45-degree field of view
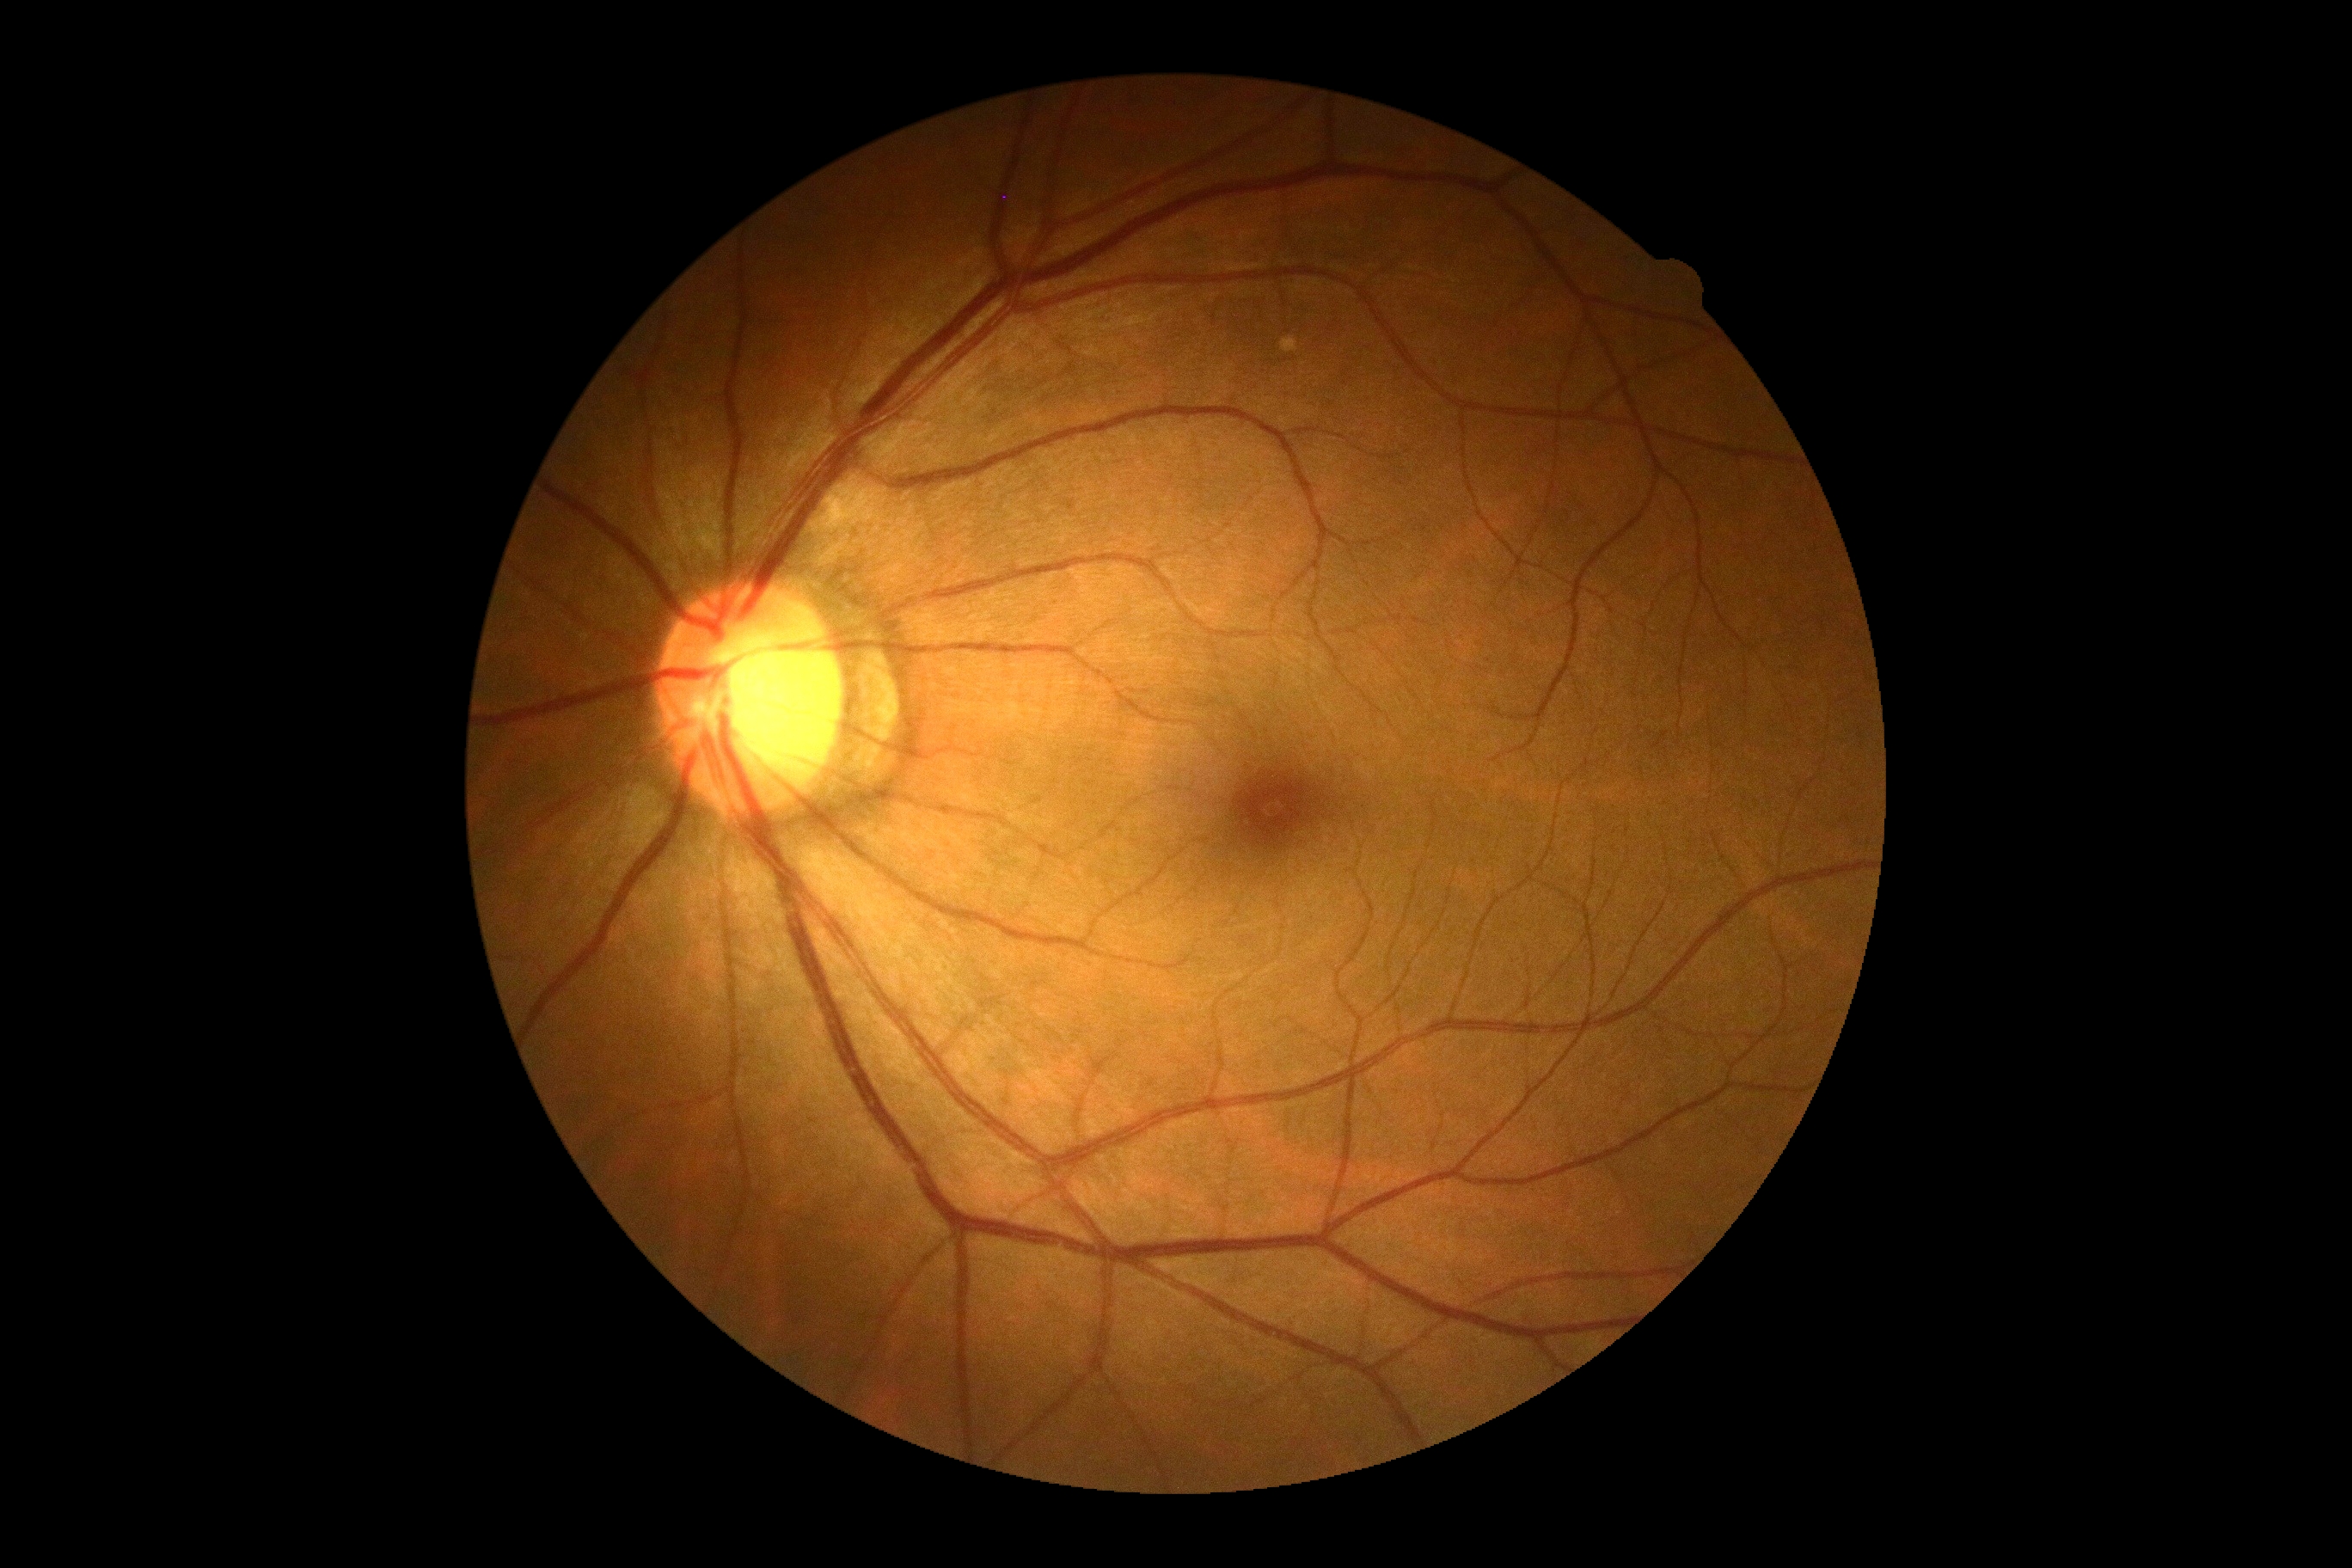
Diabetic retinopathy is 0.